Acquired on the Natus RetCam Envision; 1440 x 1080 pixels; infant wide-field fundus photograph — 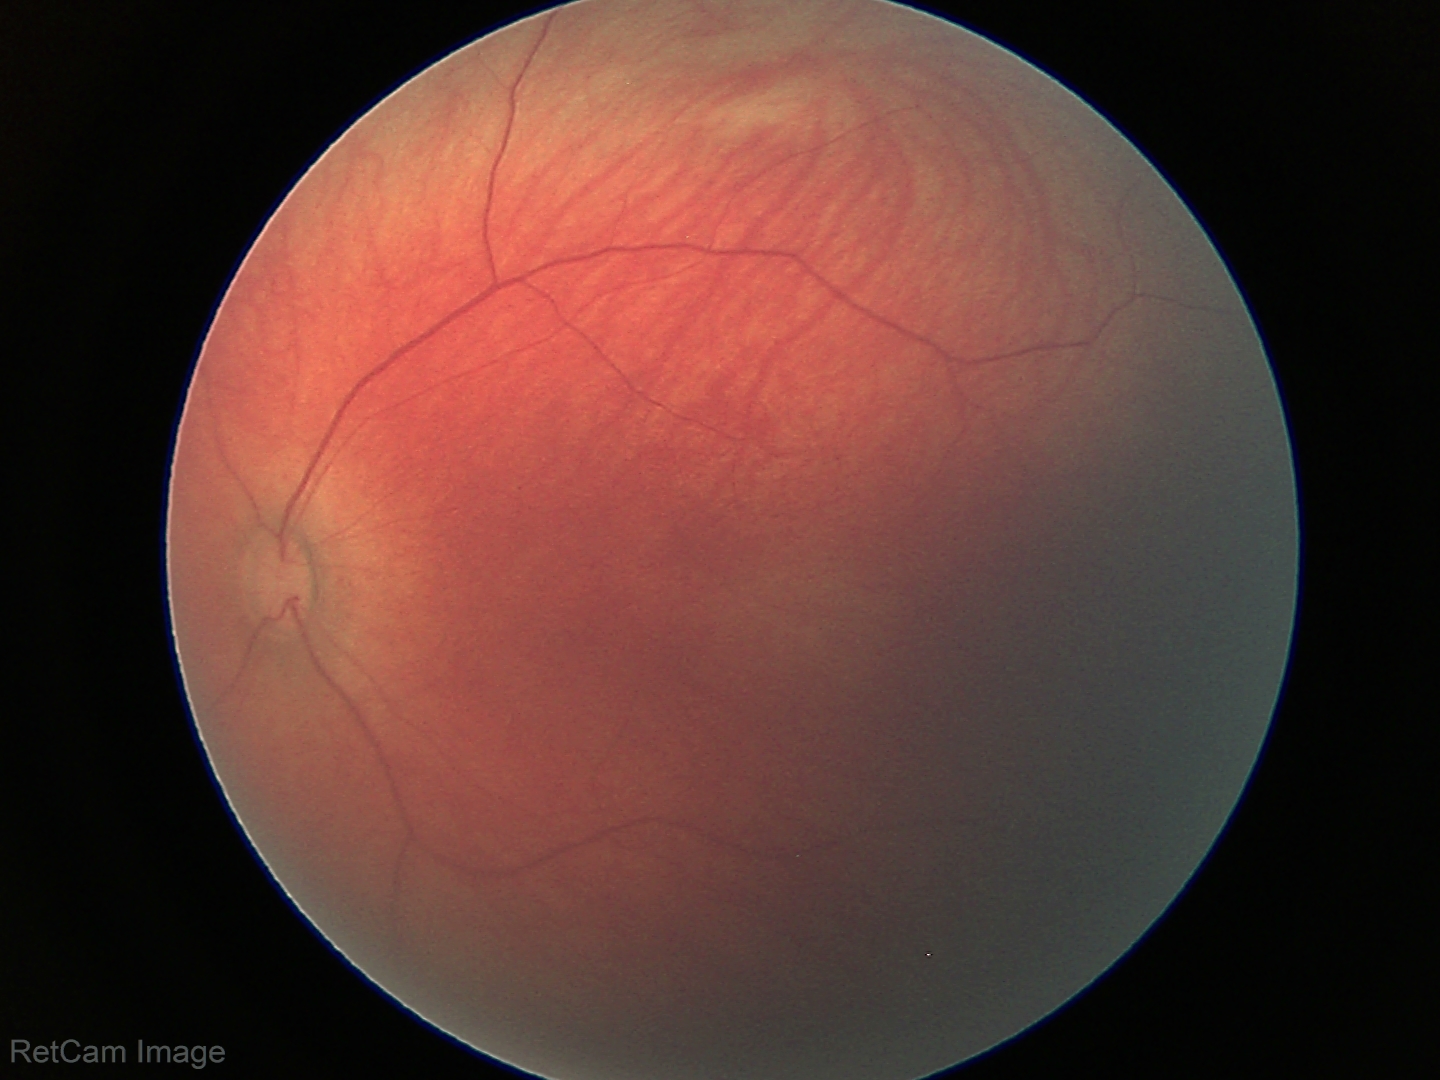
Screening examination diagnosed as physiological.